Natus RetCam Envision, 130° FOV; wide-field contact fundus photograph of an infant.
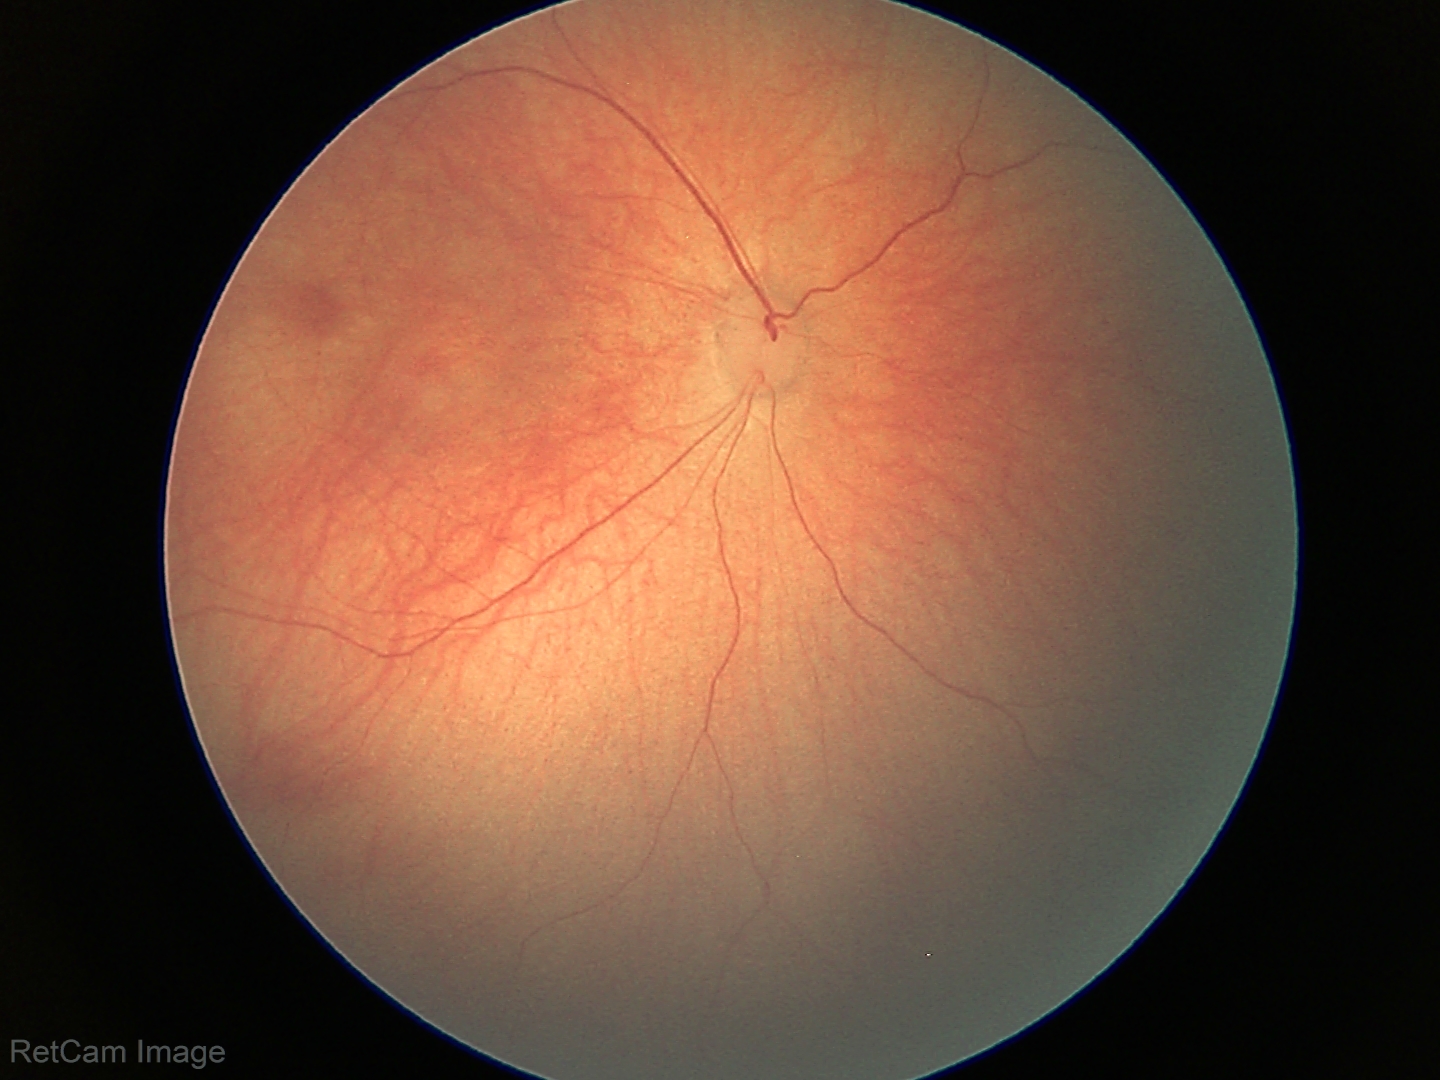 Screening: no abnormal retinal findings.